Camera: Phoenix ICON (100° FOV) · 1240 by 1240 pixels · wide-field fundus photograph from neonatal ROP screening — 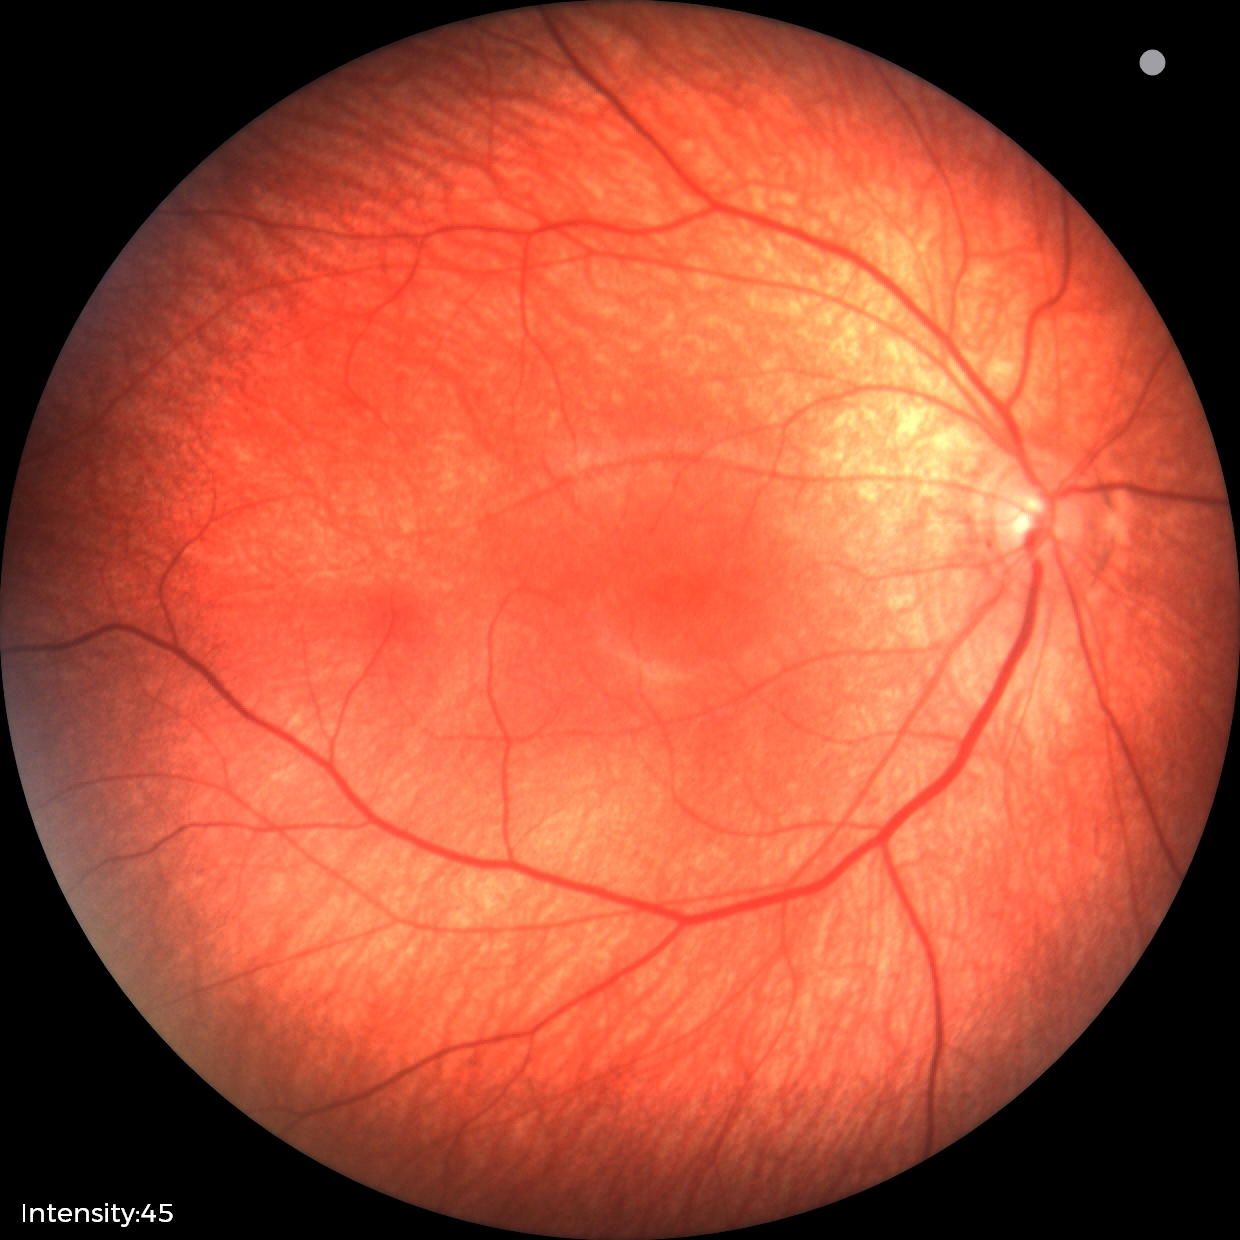 Assessment = normal retinal appearance.